60-degree field of view; 2212x1659px; handheld portable fundus camera image: 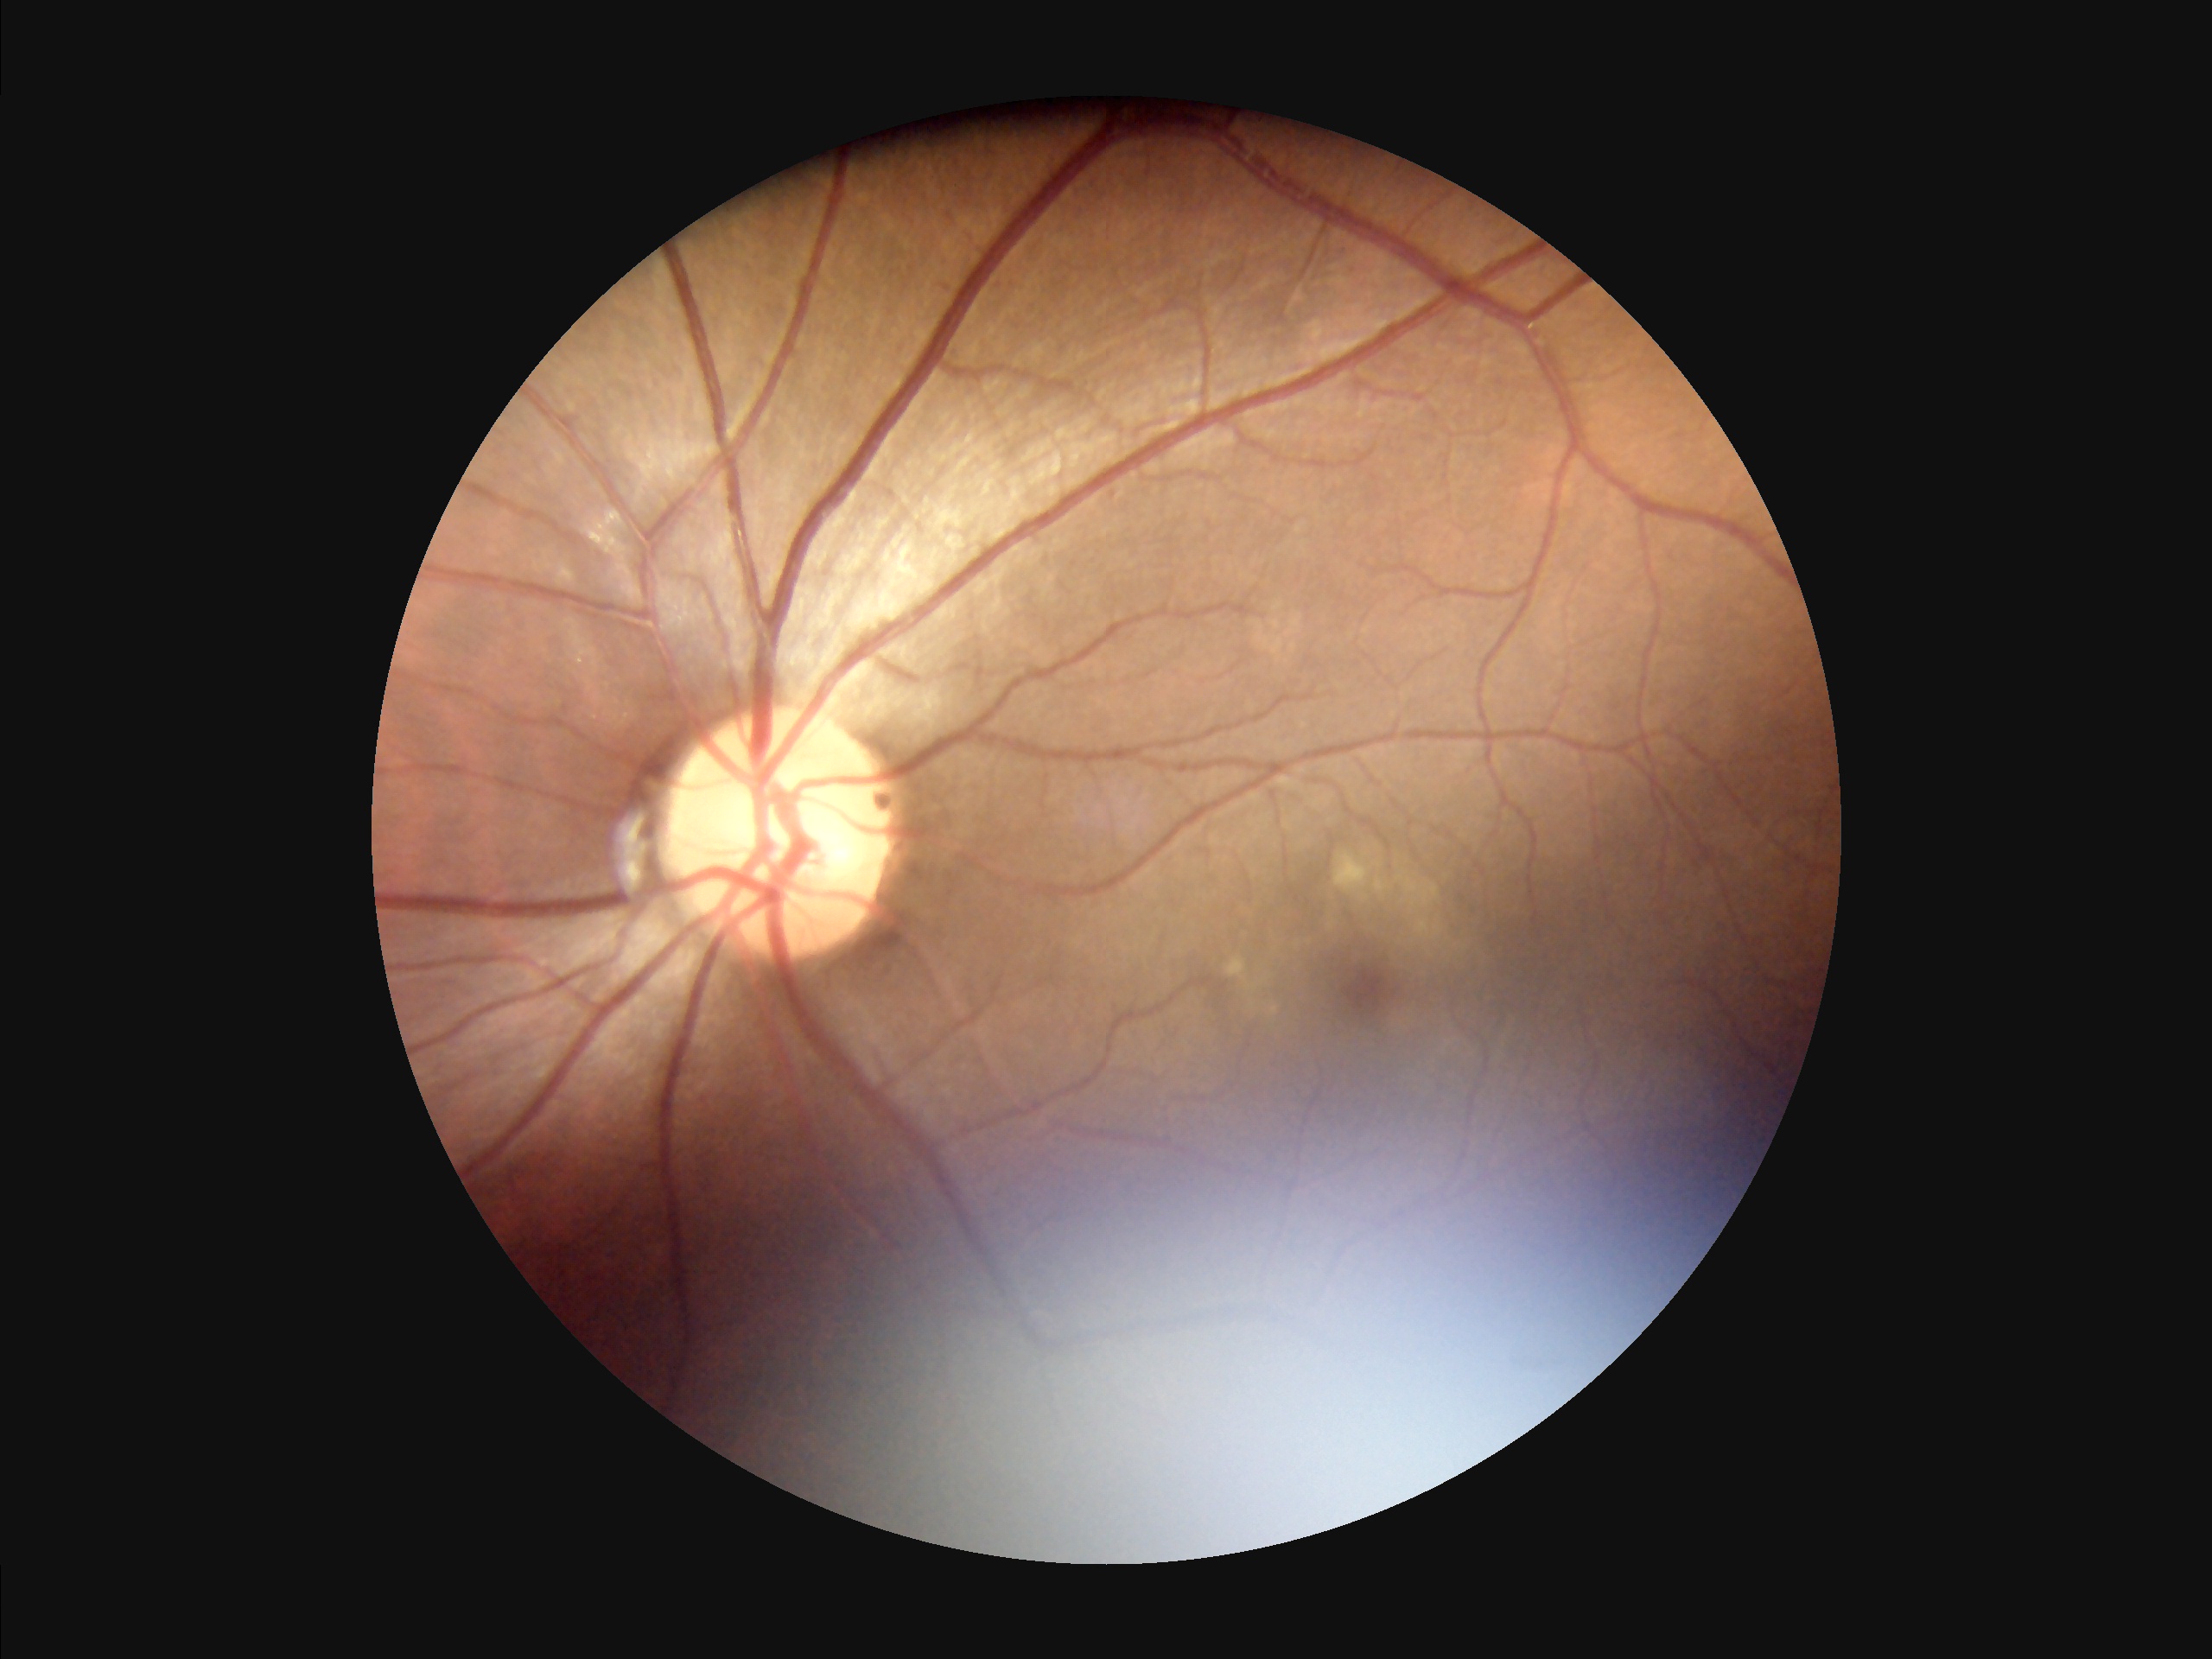
Illumination is uneven. Adequate contrast for distinguishing structures. Out of focus; structures are indistinct. Image quality is suboptimal.